Optic disc-centered crop. Retinal fundus photograph. Nidek AFC-330.
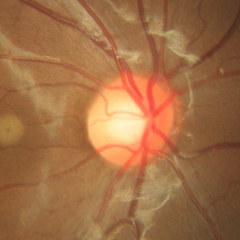 No evidence of glaucoma.